CFP, 848x848, NIDEK AFC-230 fundus camera
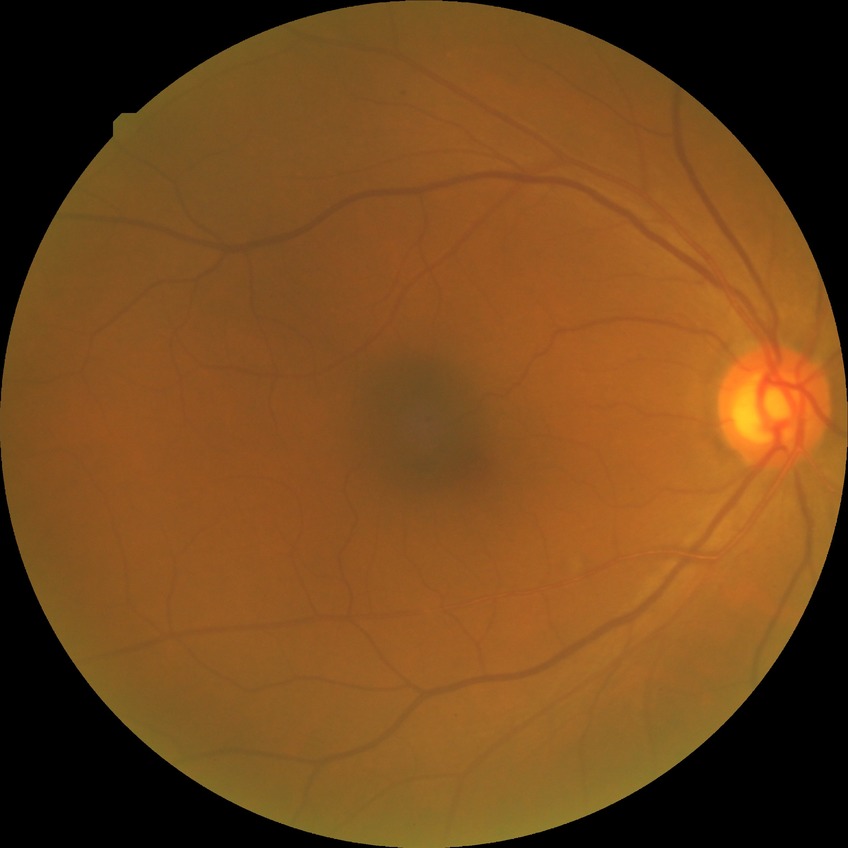 Diabetic retinopathy (DR): SDR (simple diabetic retinopathy).